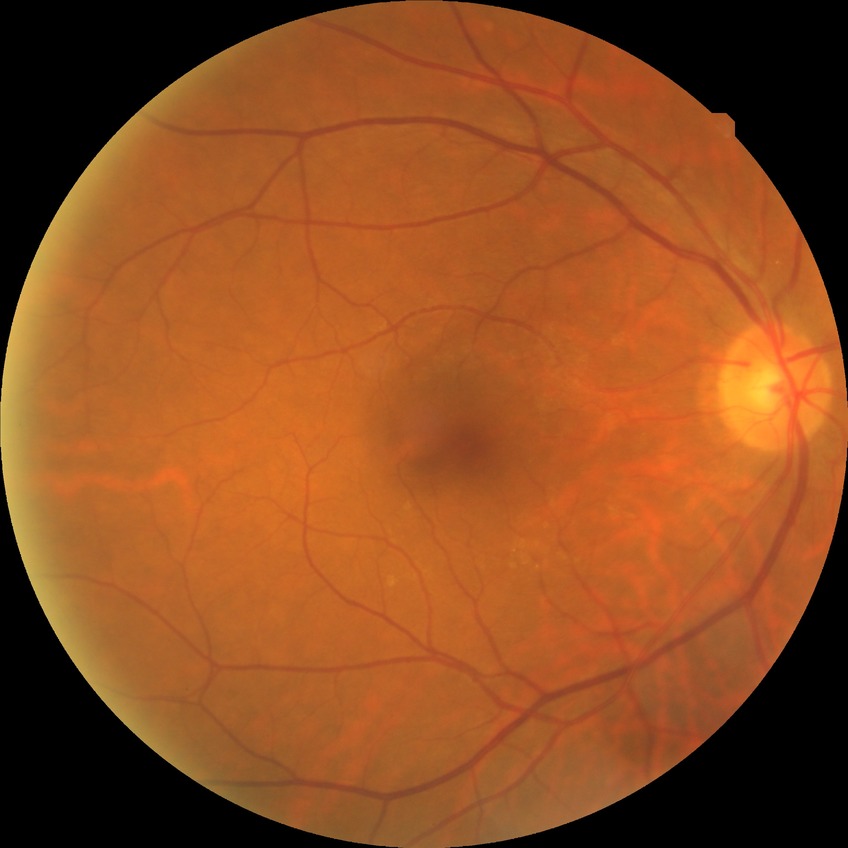
  davis_grade: NDR (no diabetic retinopathy)